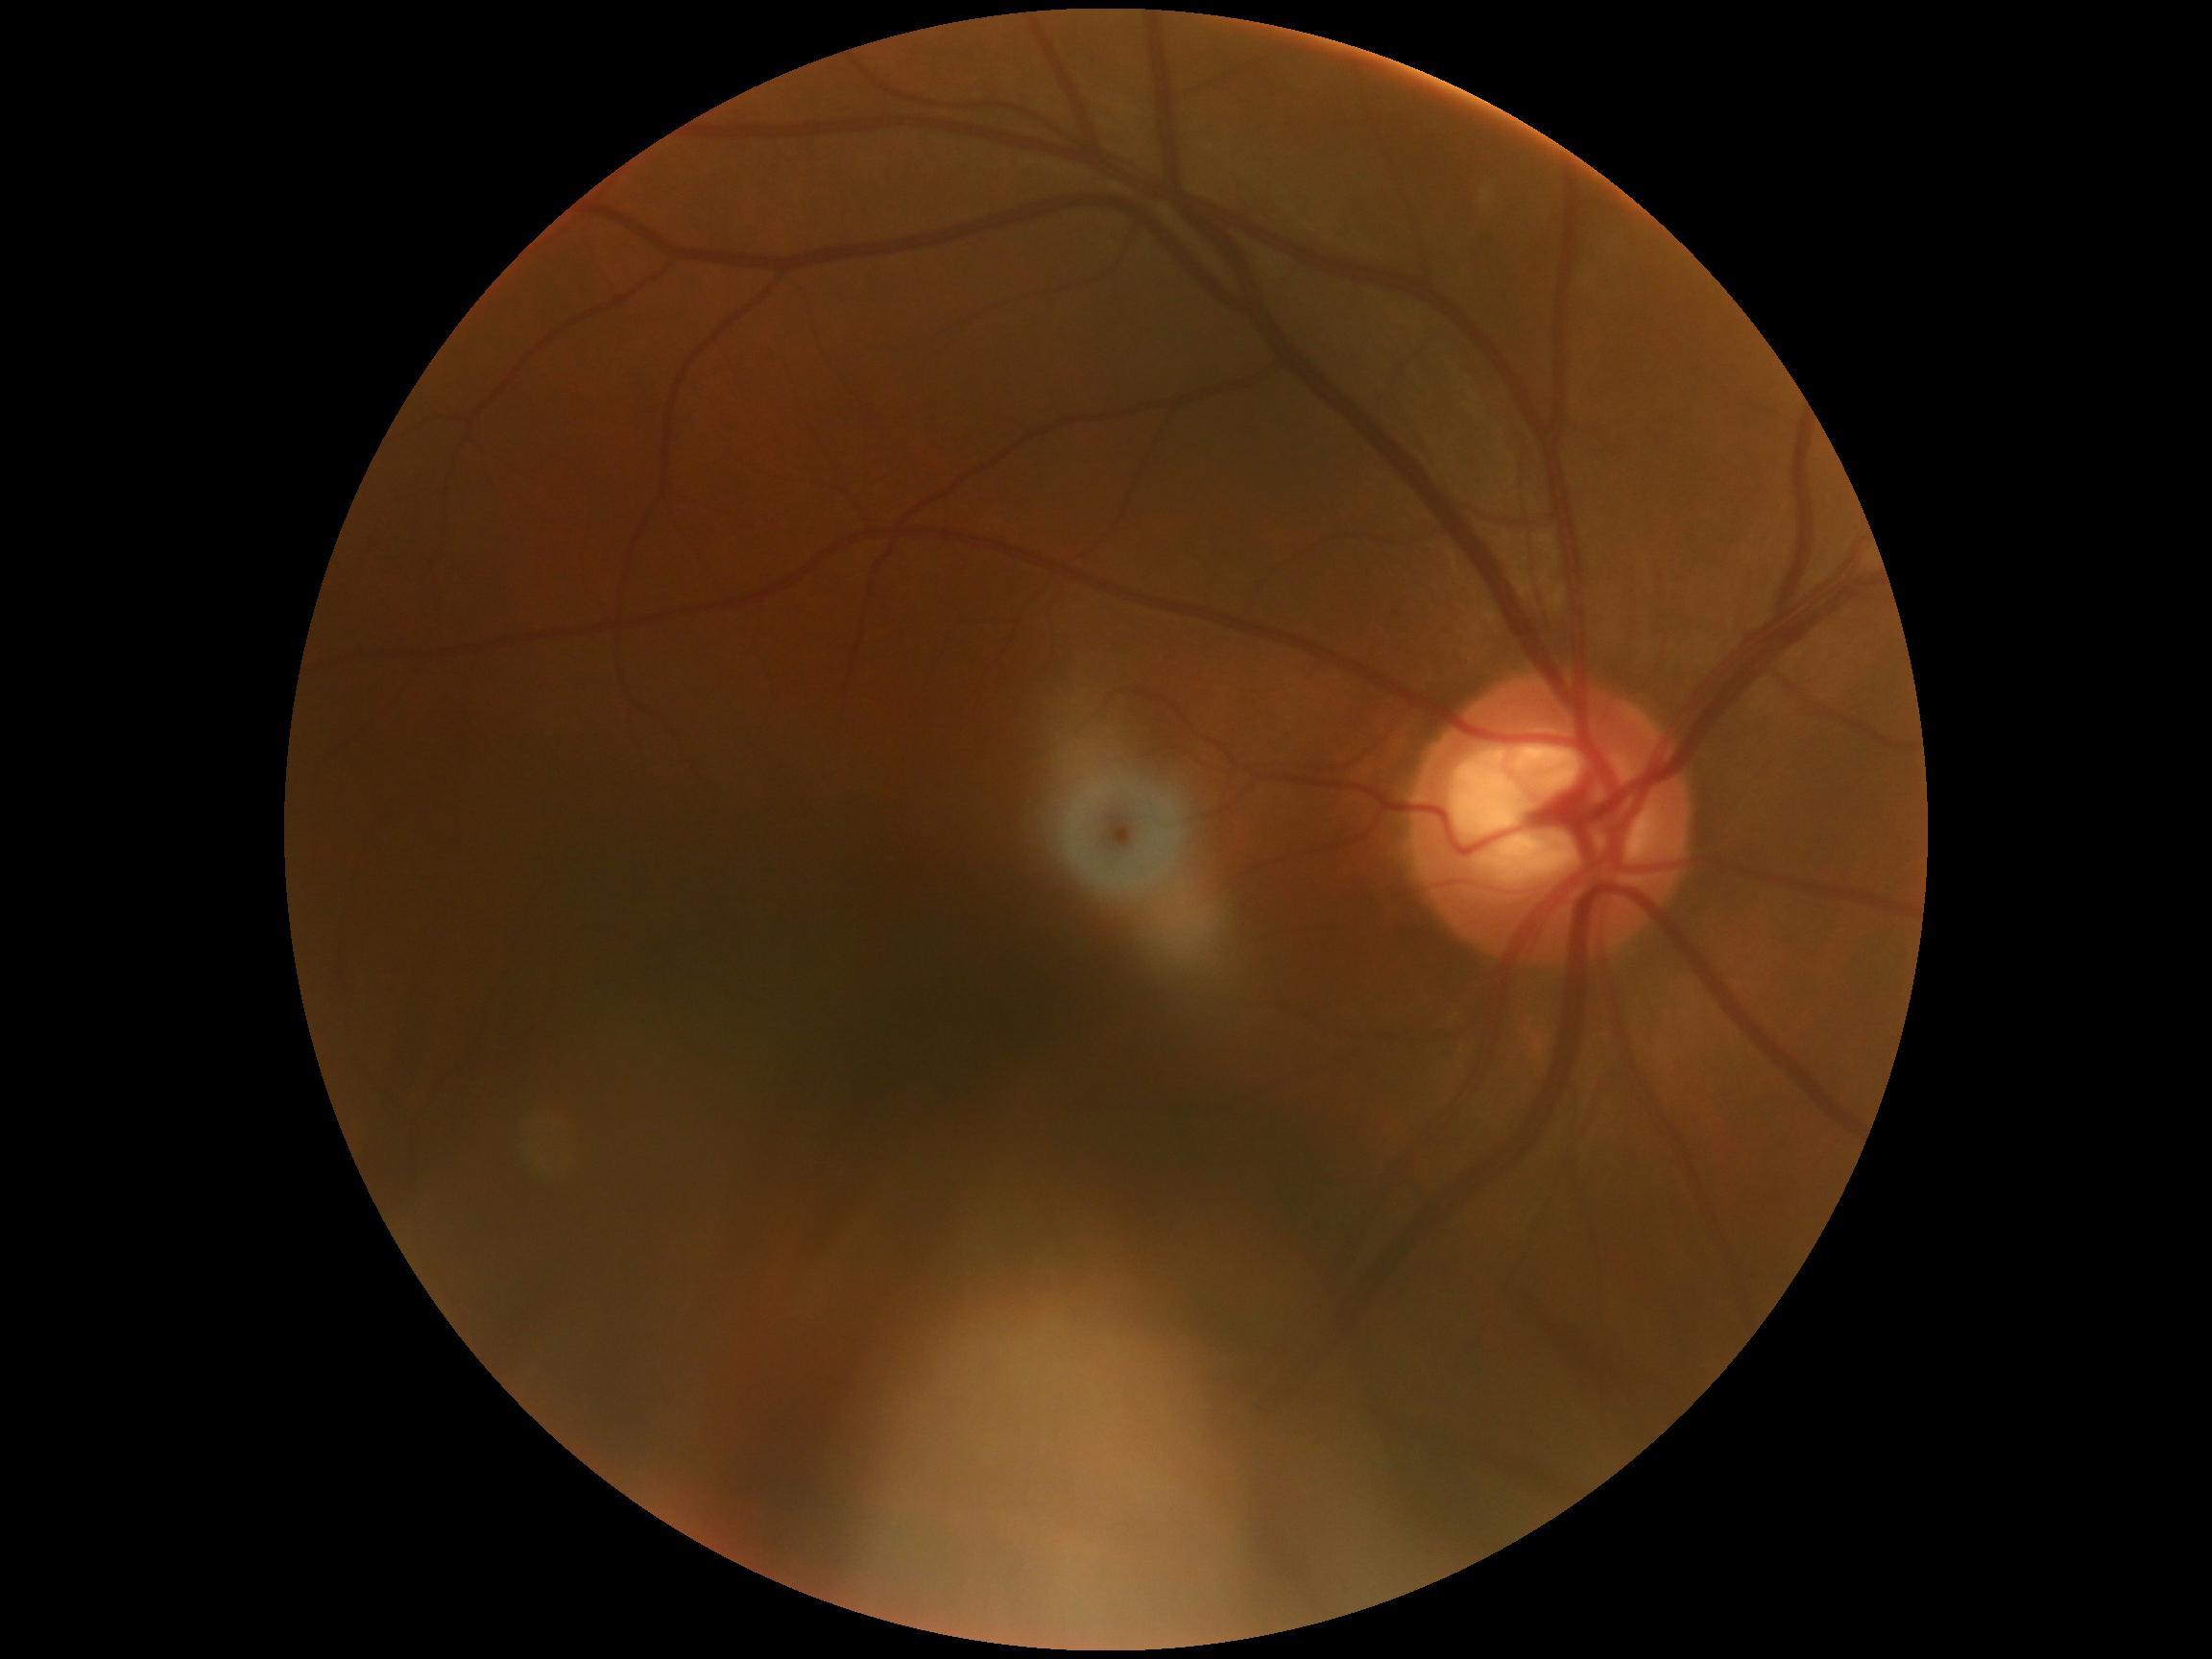

DR severity is 0. No DR findings.